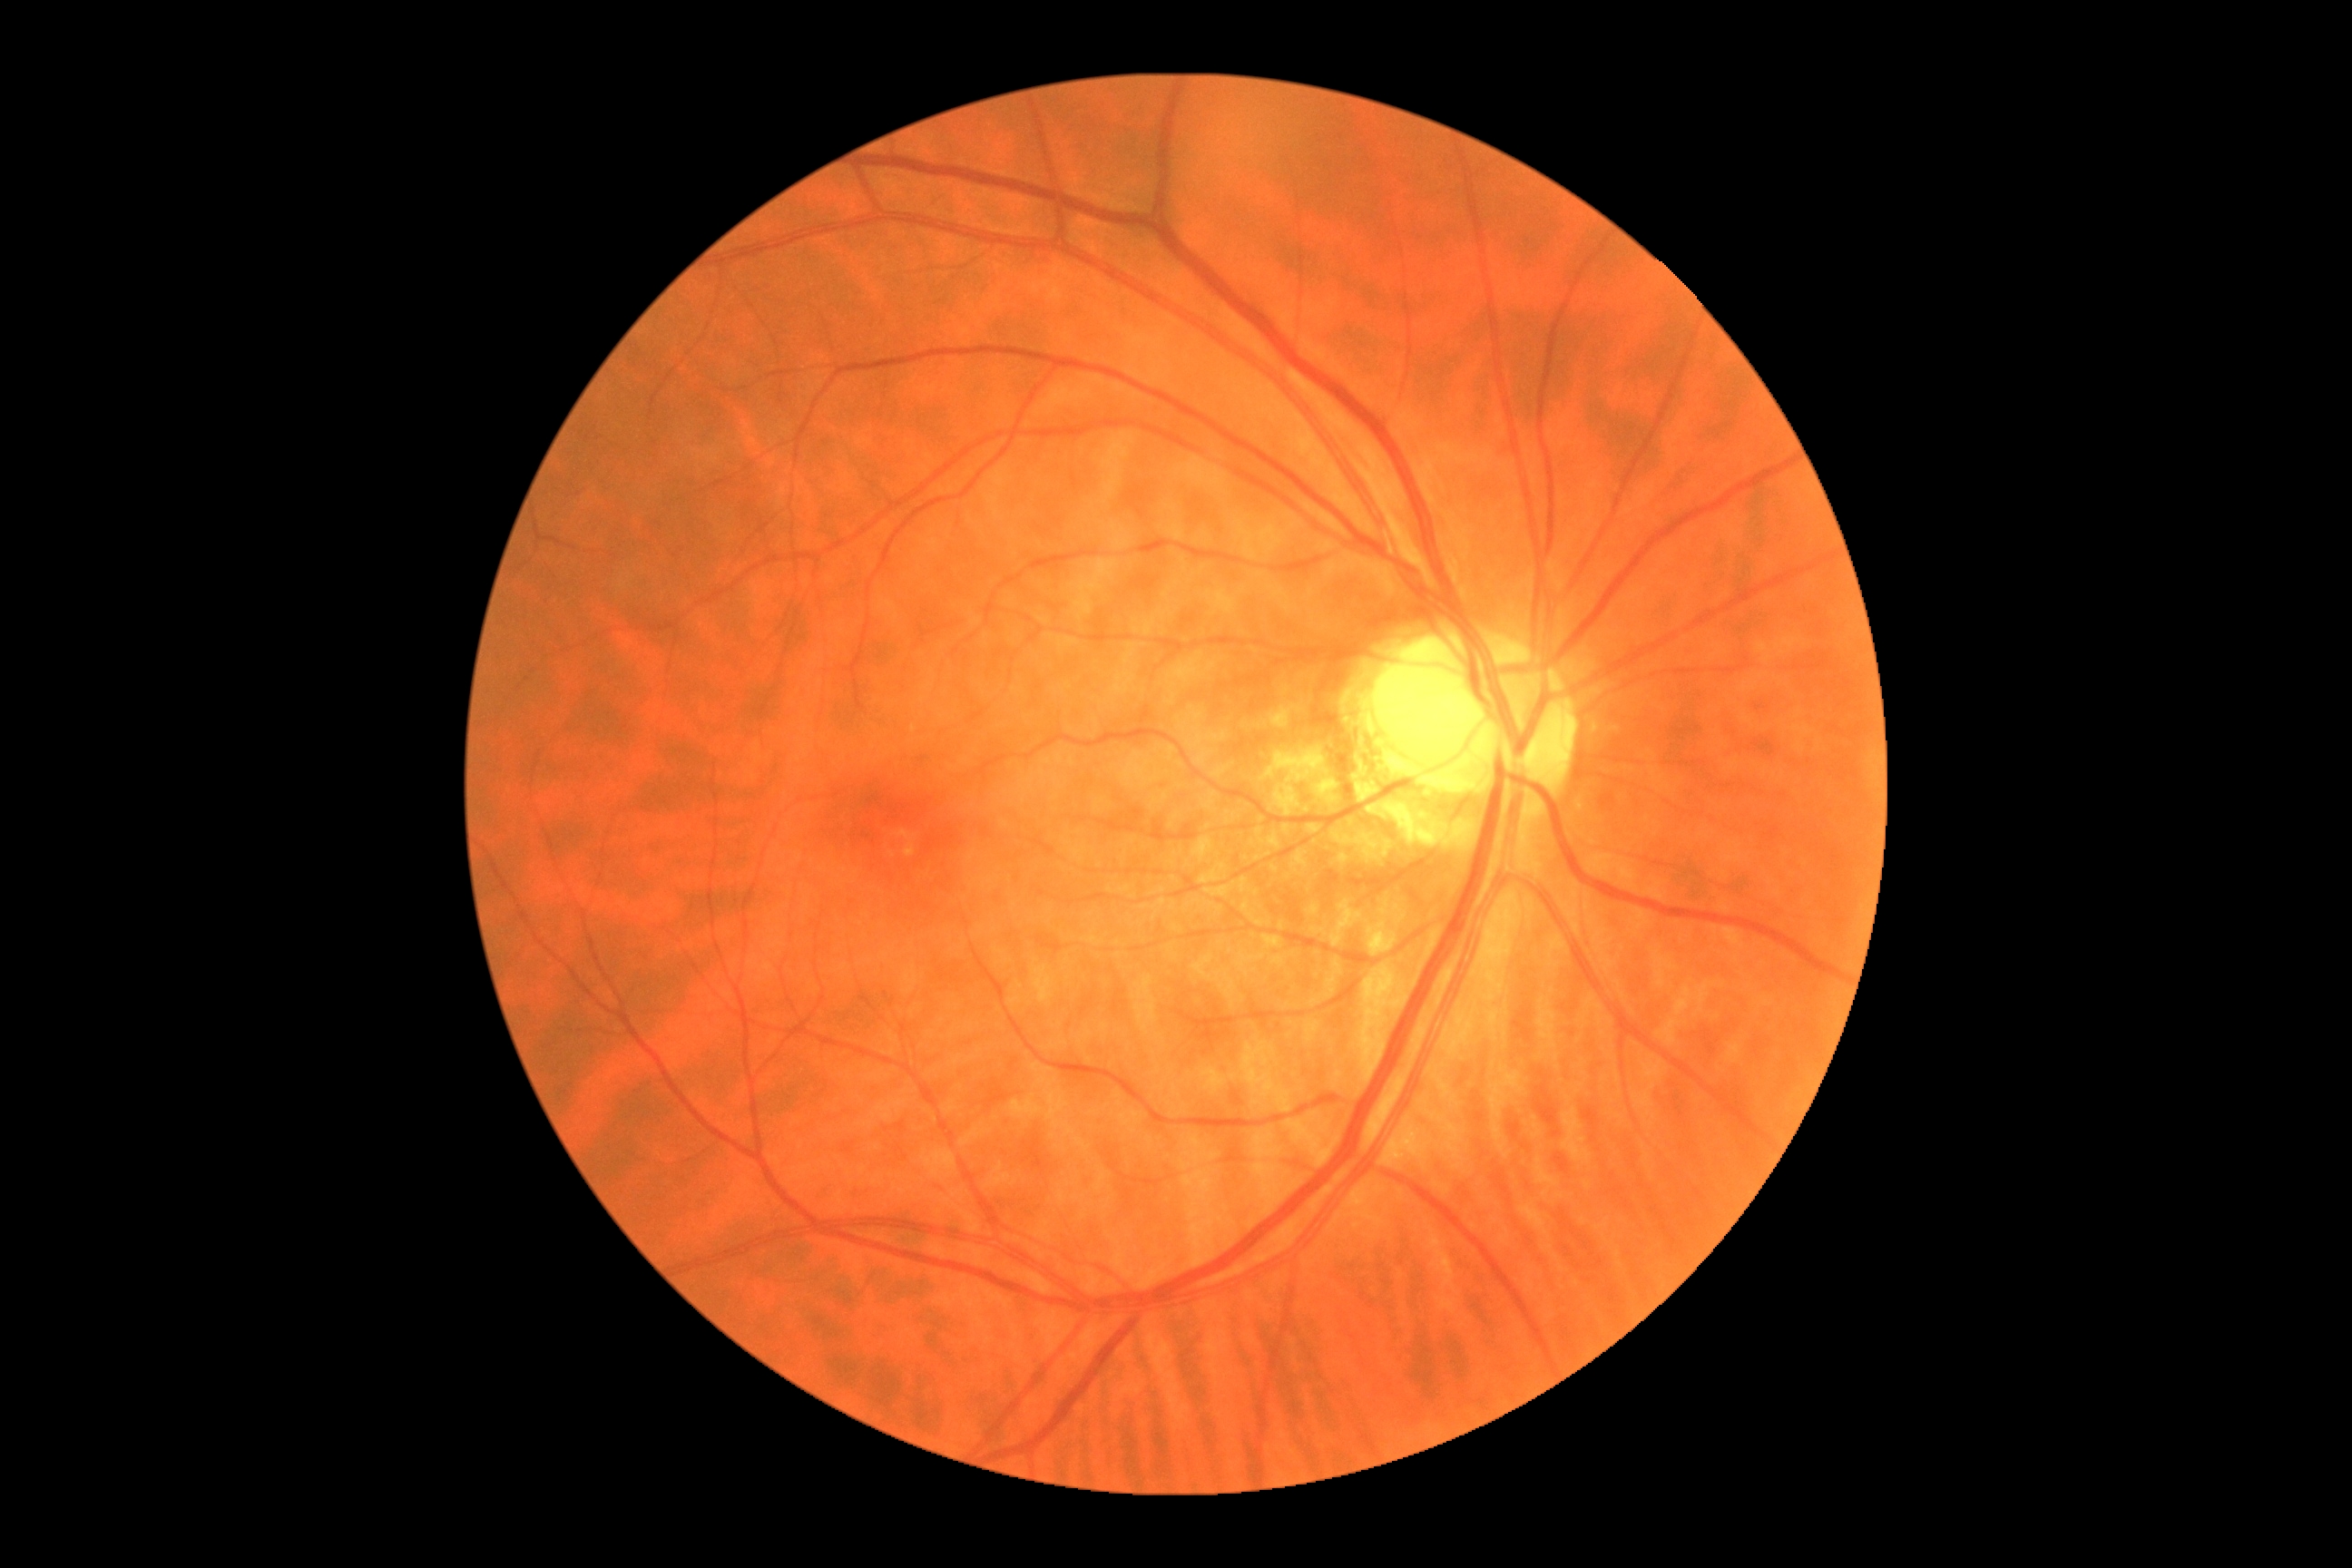
Retinopathy grade: 0.